Pediatric retinal photograph (wide-field).
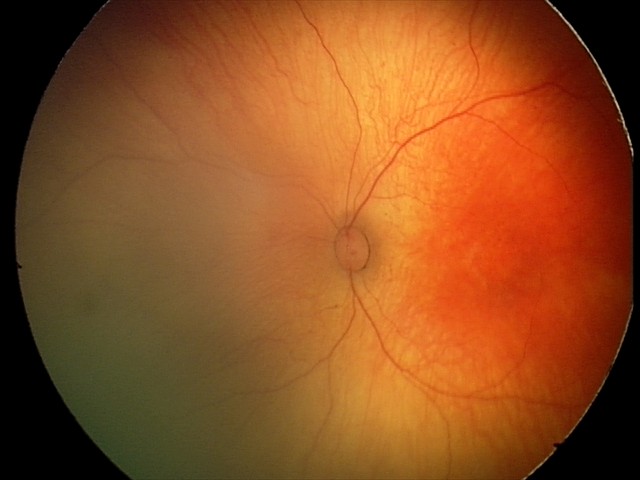
Normal screening examination.